Fundus photo.
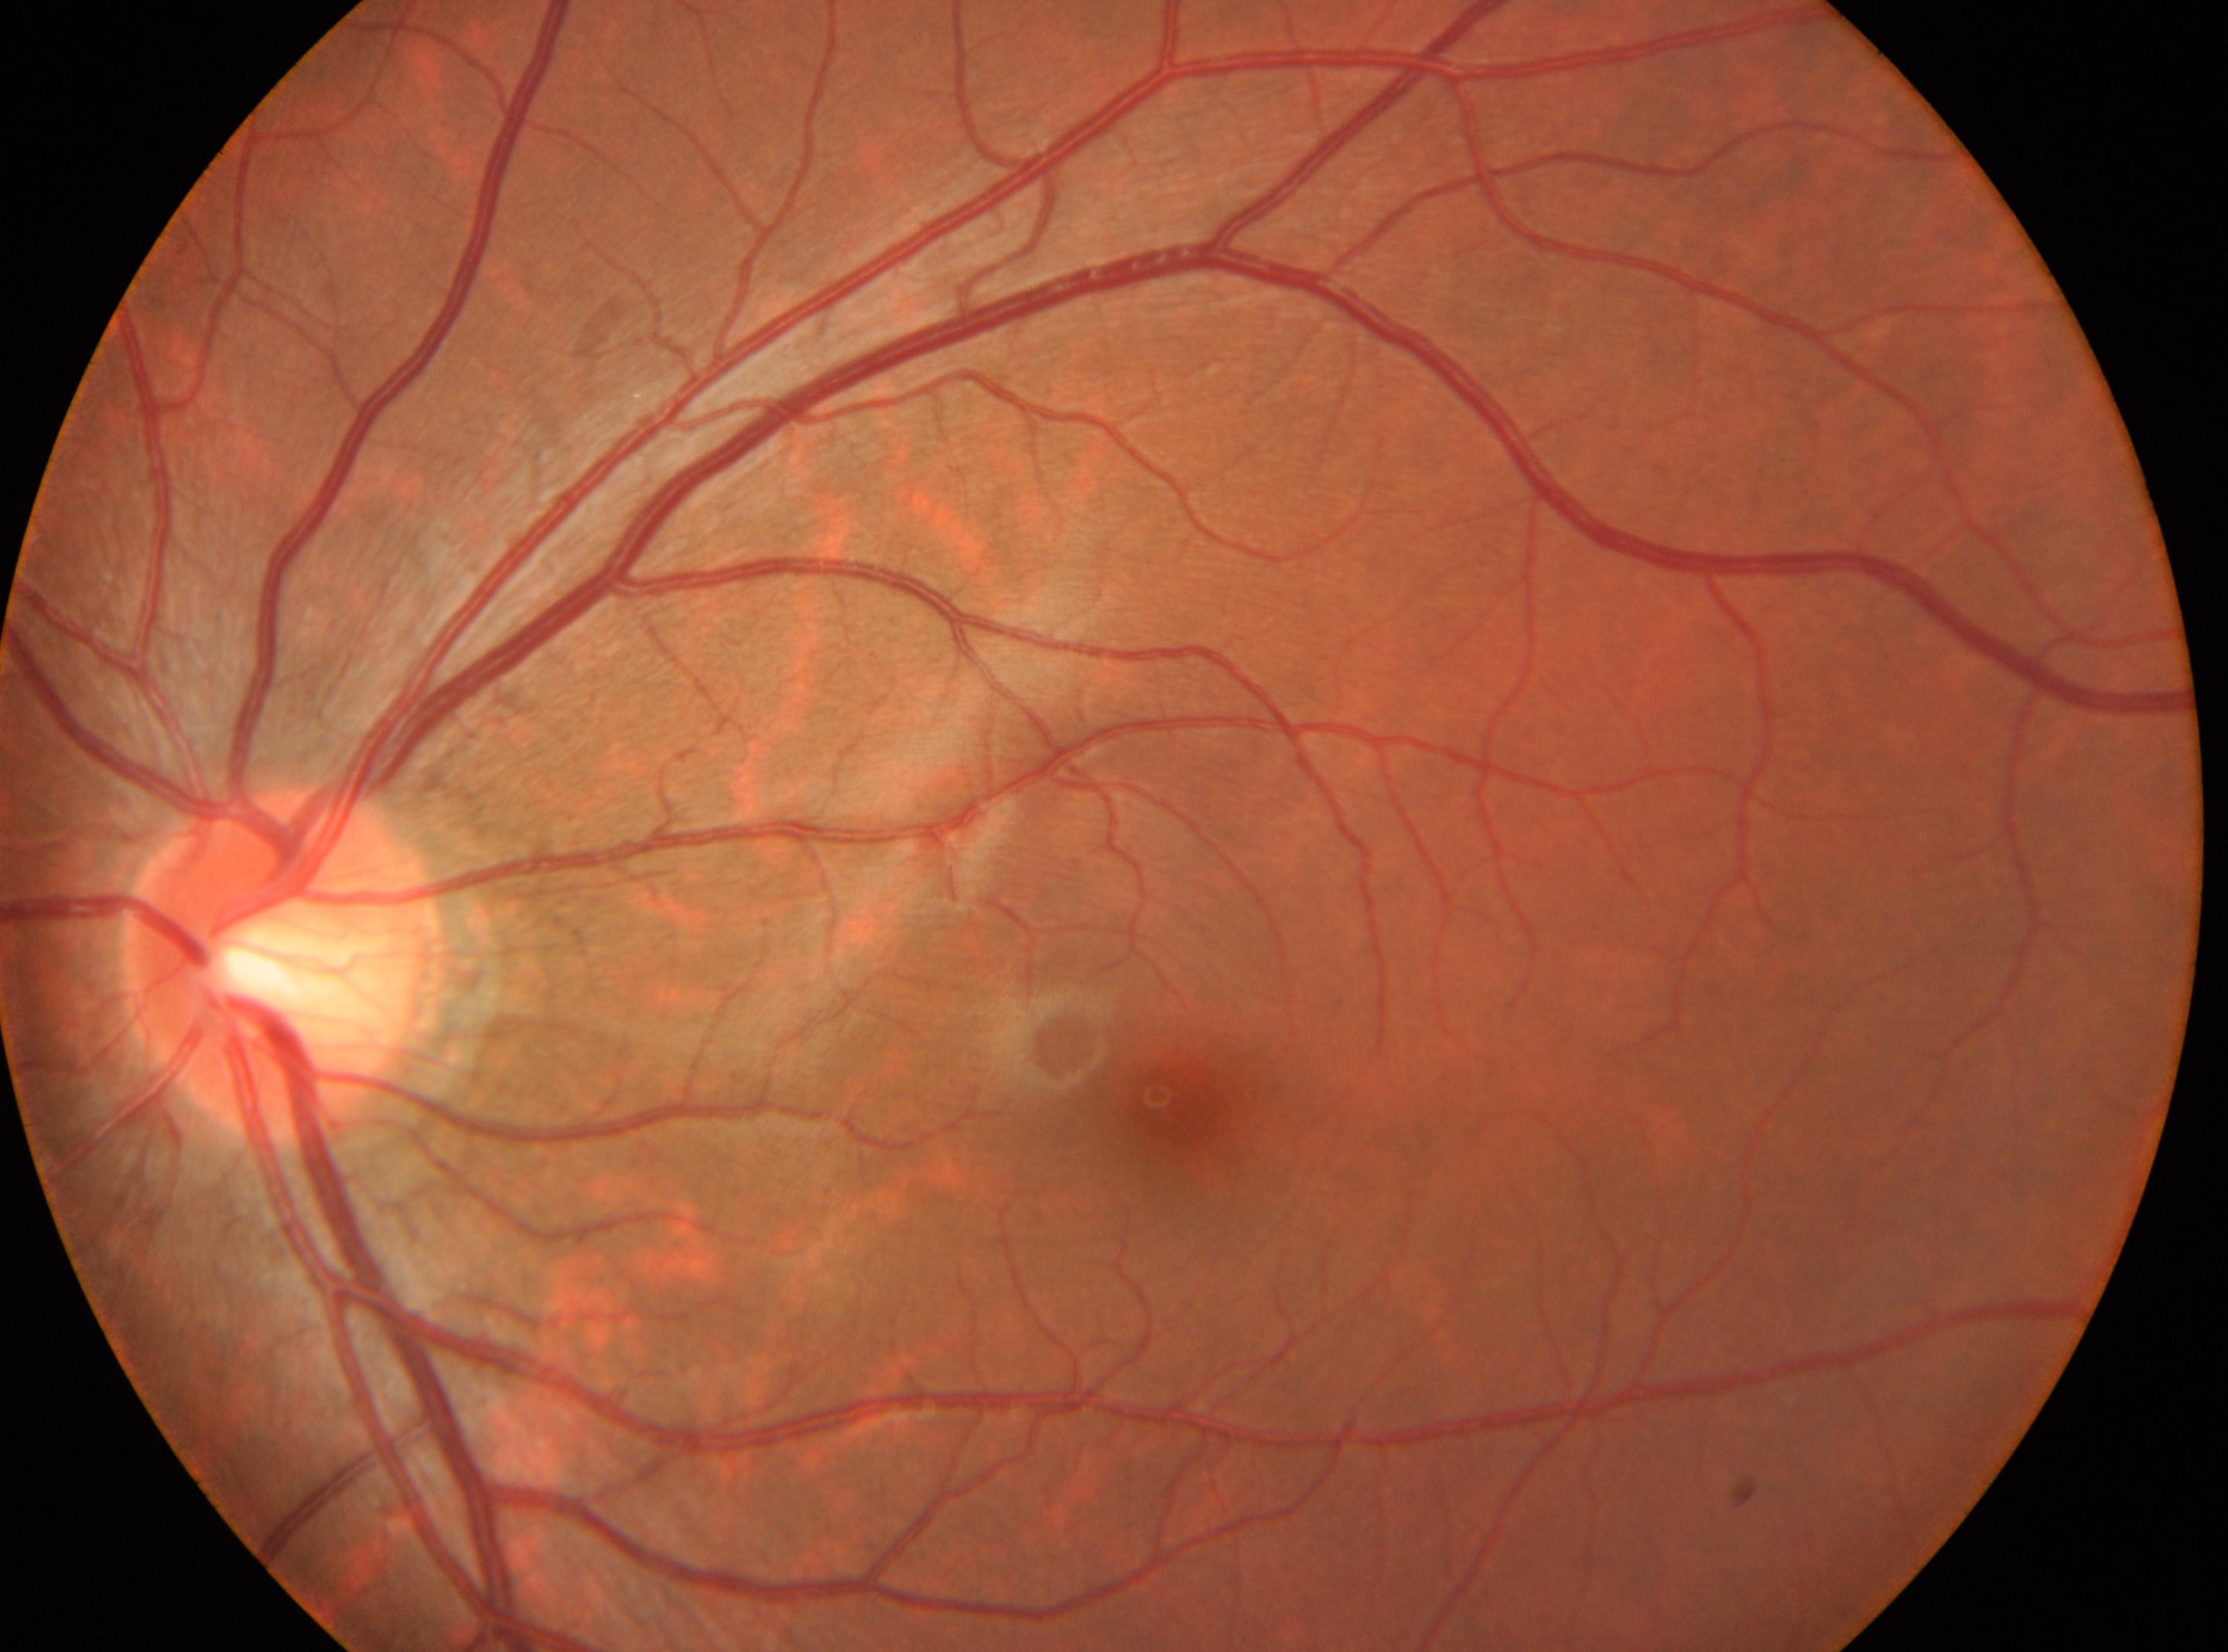

Annotations:
* DR — grade 0 (no apparent retinopathy)
* optic disc — 282, 965
* fovea centralis — 1179, 1101
* eye — OS